2352 by 1568 pixels: 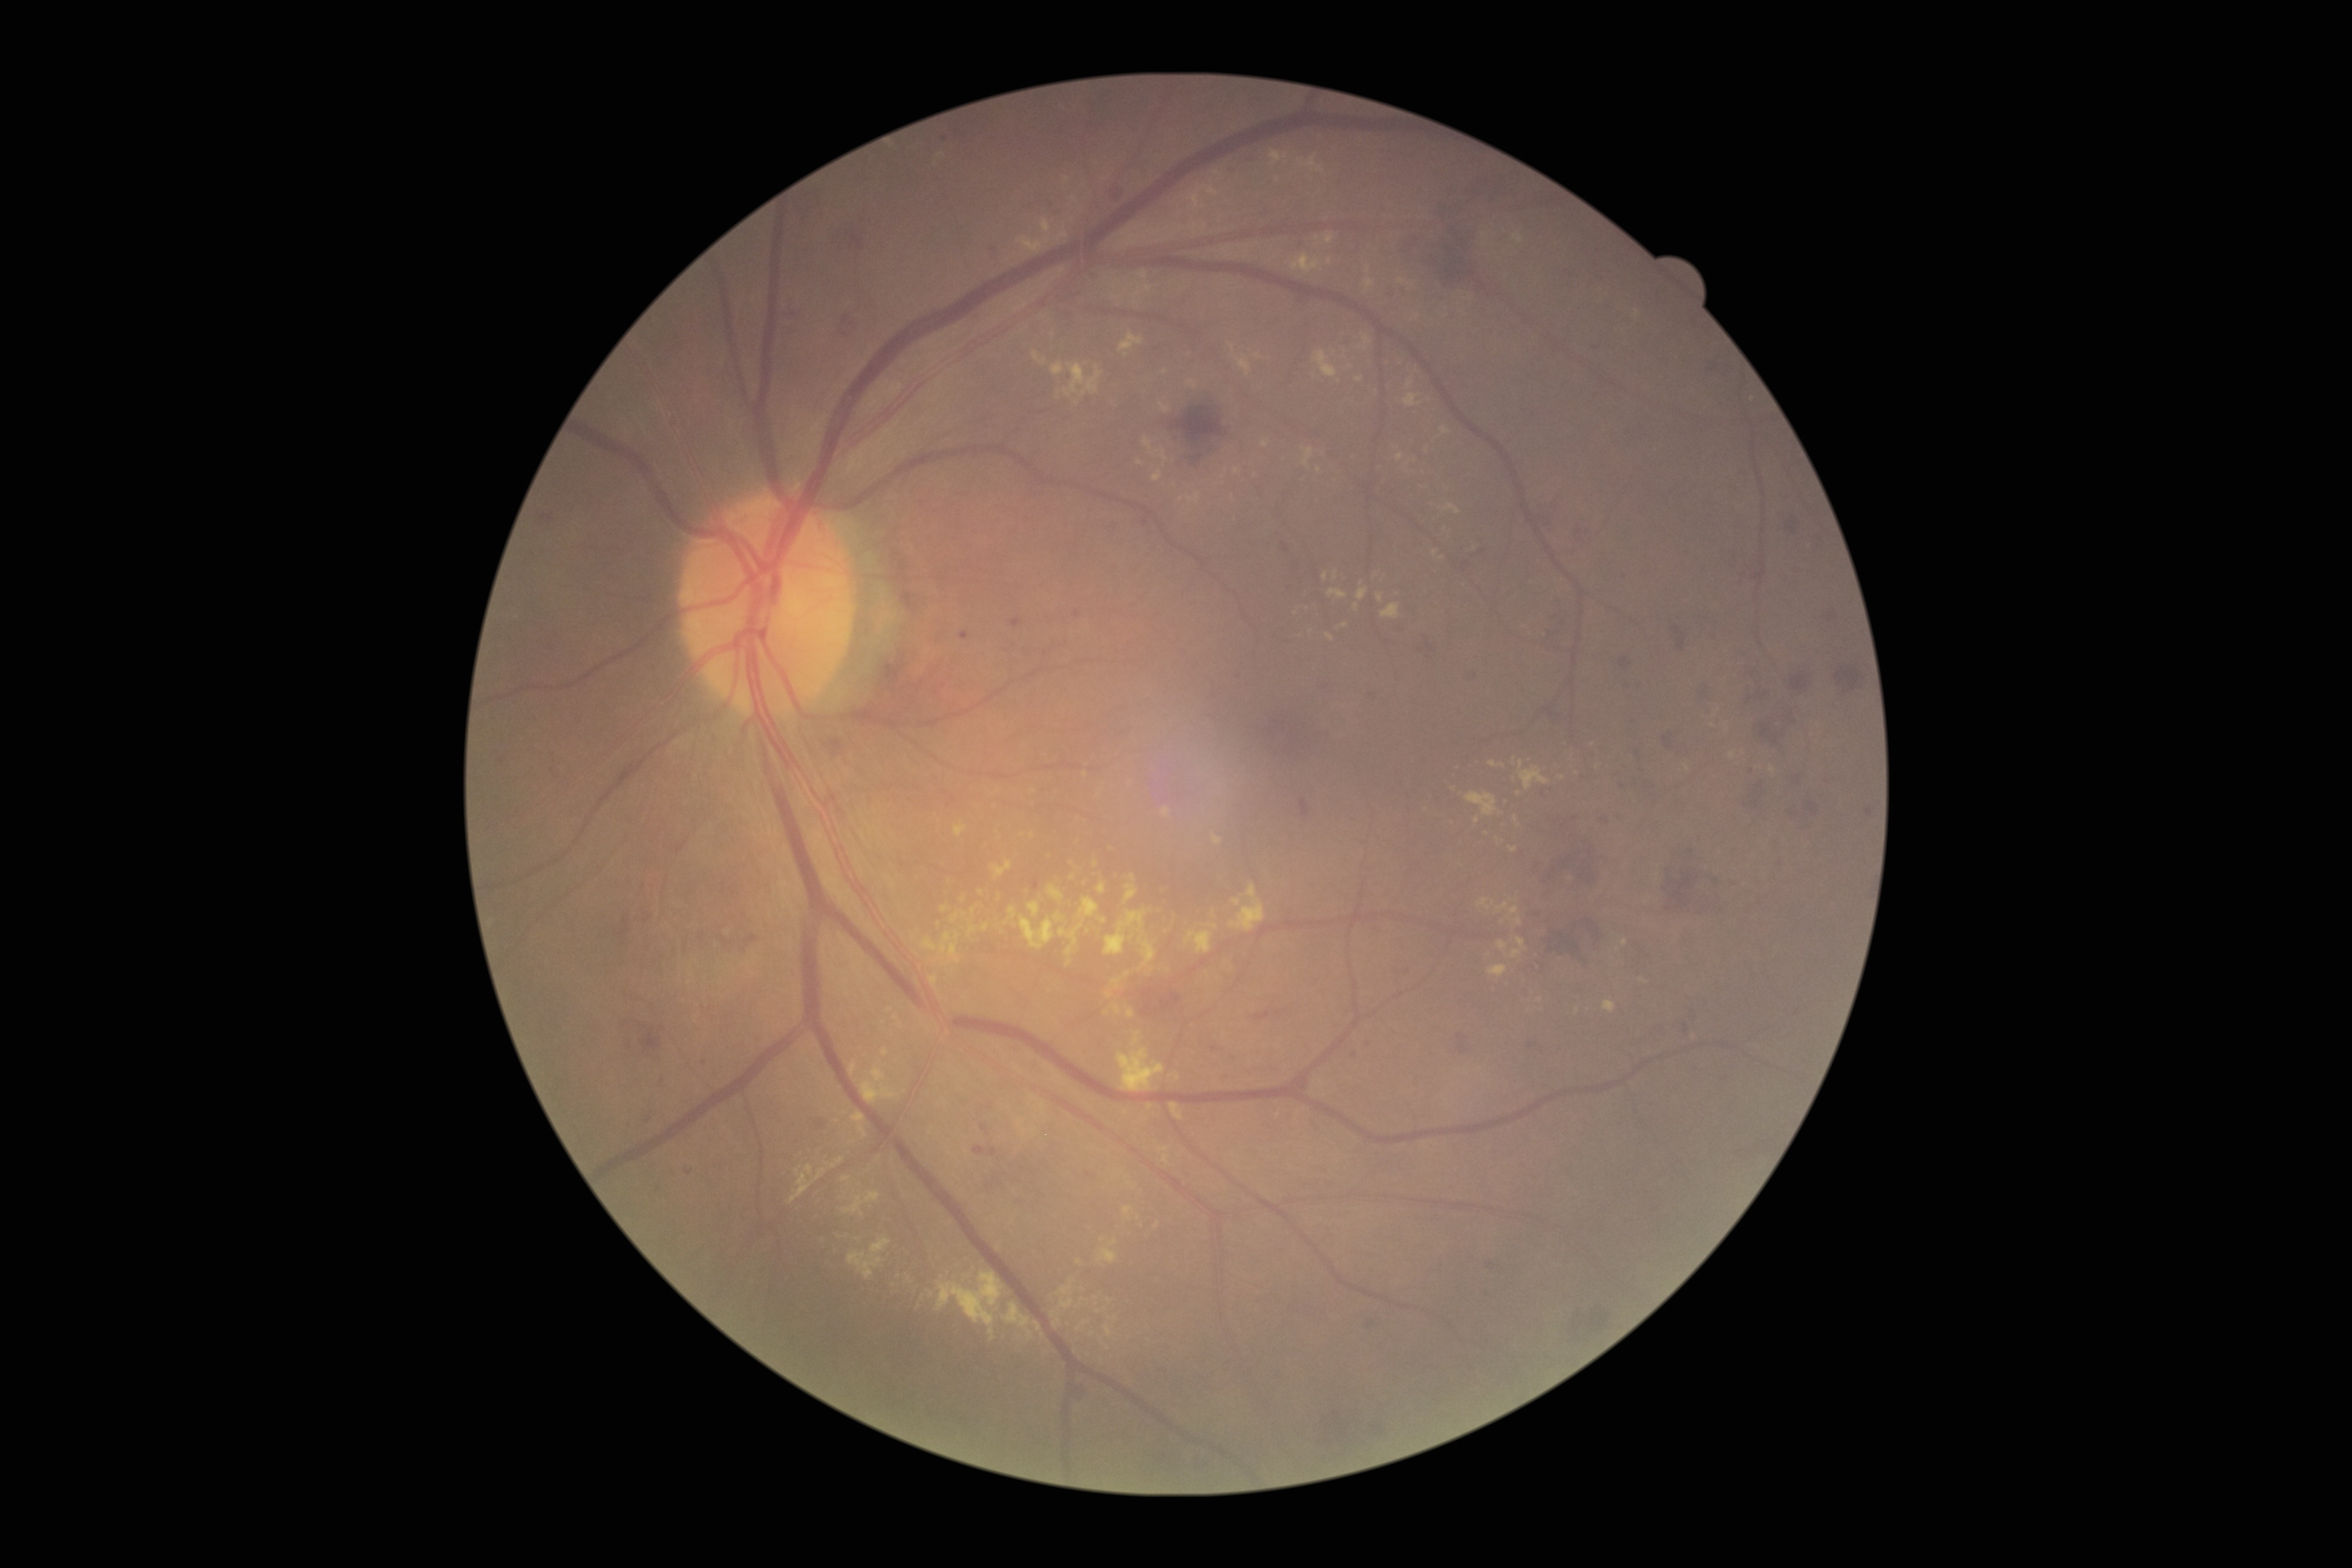
{"partial": true, "dr_grade": 2, "lesions": {"ex": [[1111, 971, 1132, 989], [982, 924, 989, 932], [1185, 931, 1213, 953], [1060, 1285, 1073, 1294], [1098, 884, 1106, 893], [1133, 286, 1142, 301], [923, 932, 960, 962], [1163, 1155, 1169, 1163], [1604, 1000, 1616, 1013], [1028, 901, 1041, 916]], "ex_small_approx": [[1101, 1340], [950, 962], [1054, 1314], [1562, 778], [1431, 809], [1196, 225], [1625, 942], [981, 892]]}}